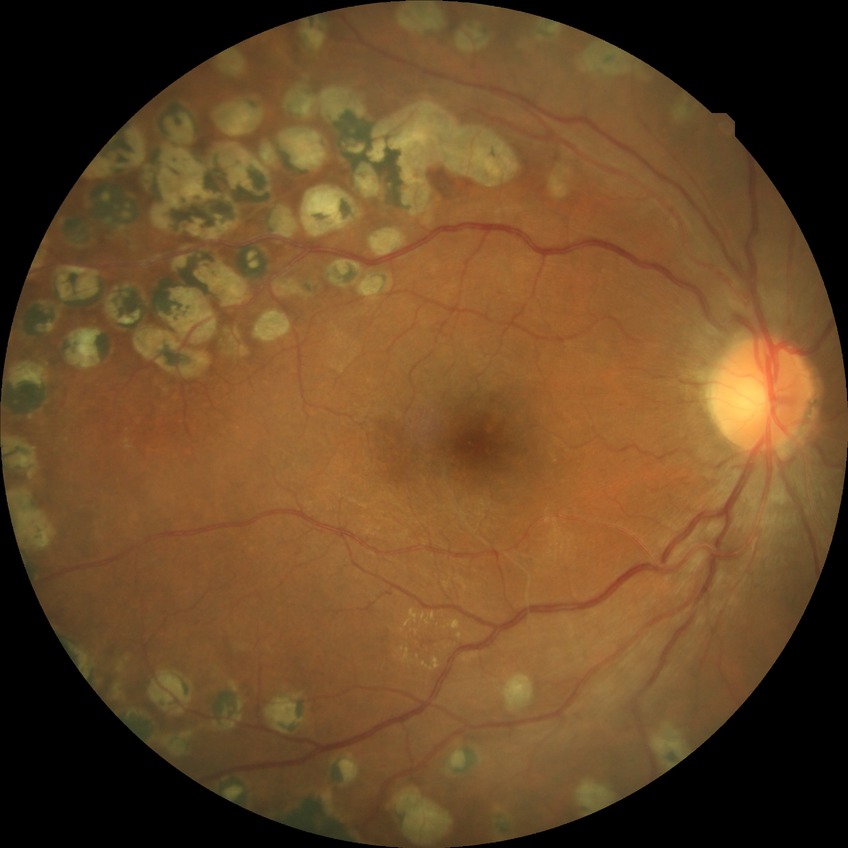
Findings:
• DR stage: PDR